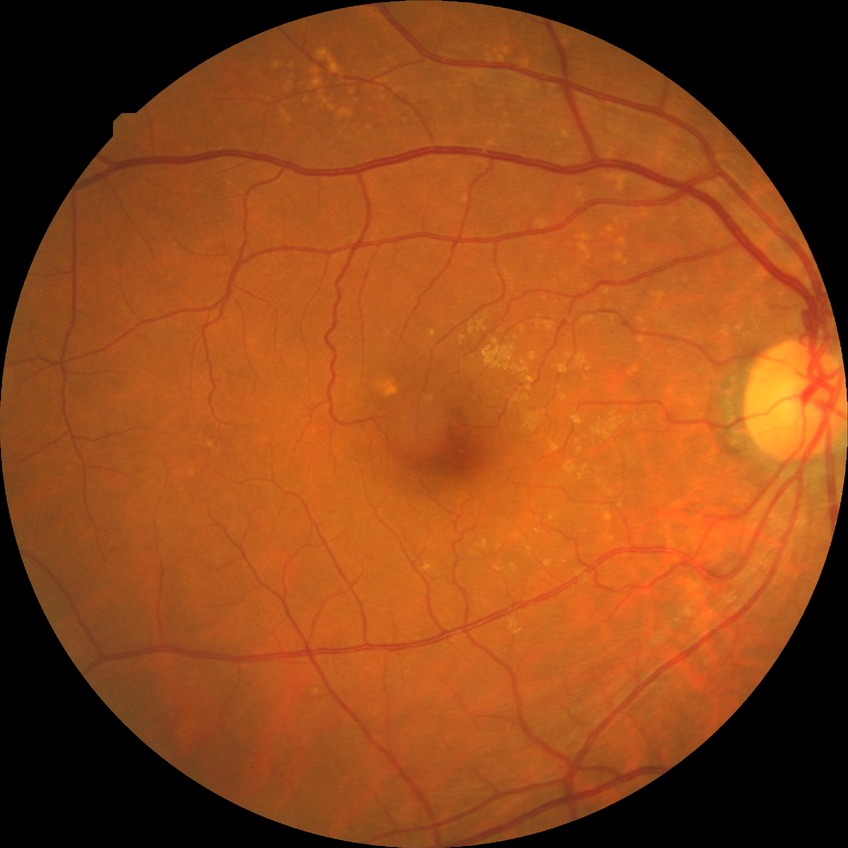

Diabetic retinopathy stage: no diabetic retinopathy.